1659 by 2212 pixels:
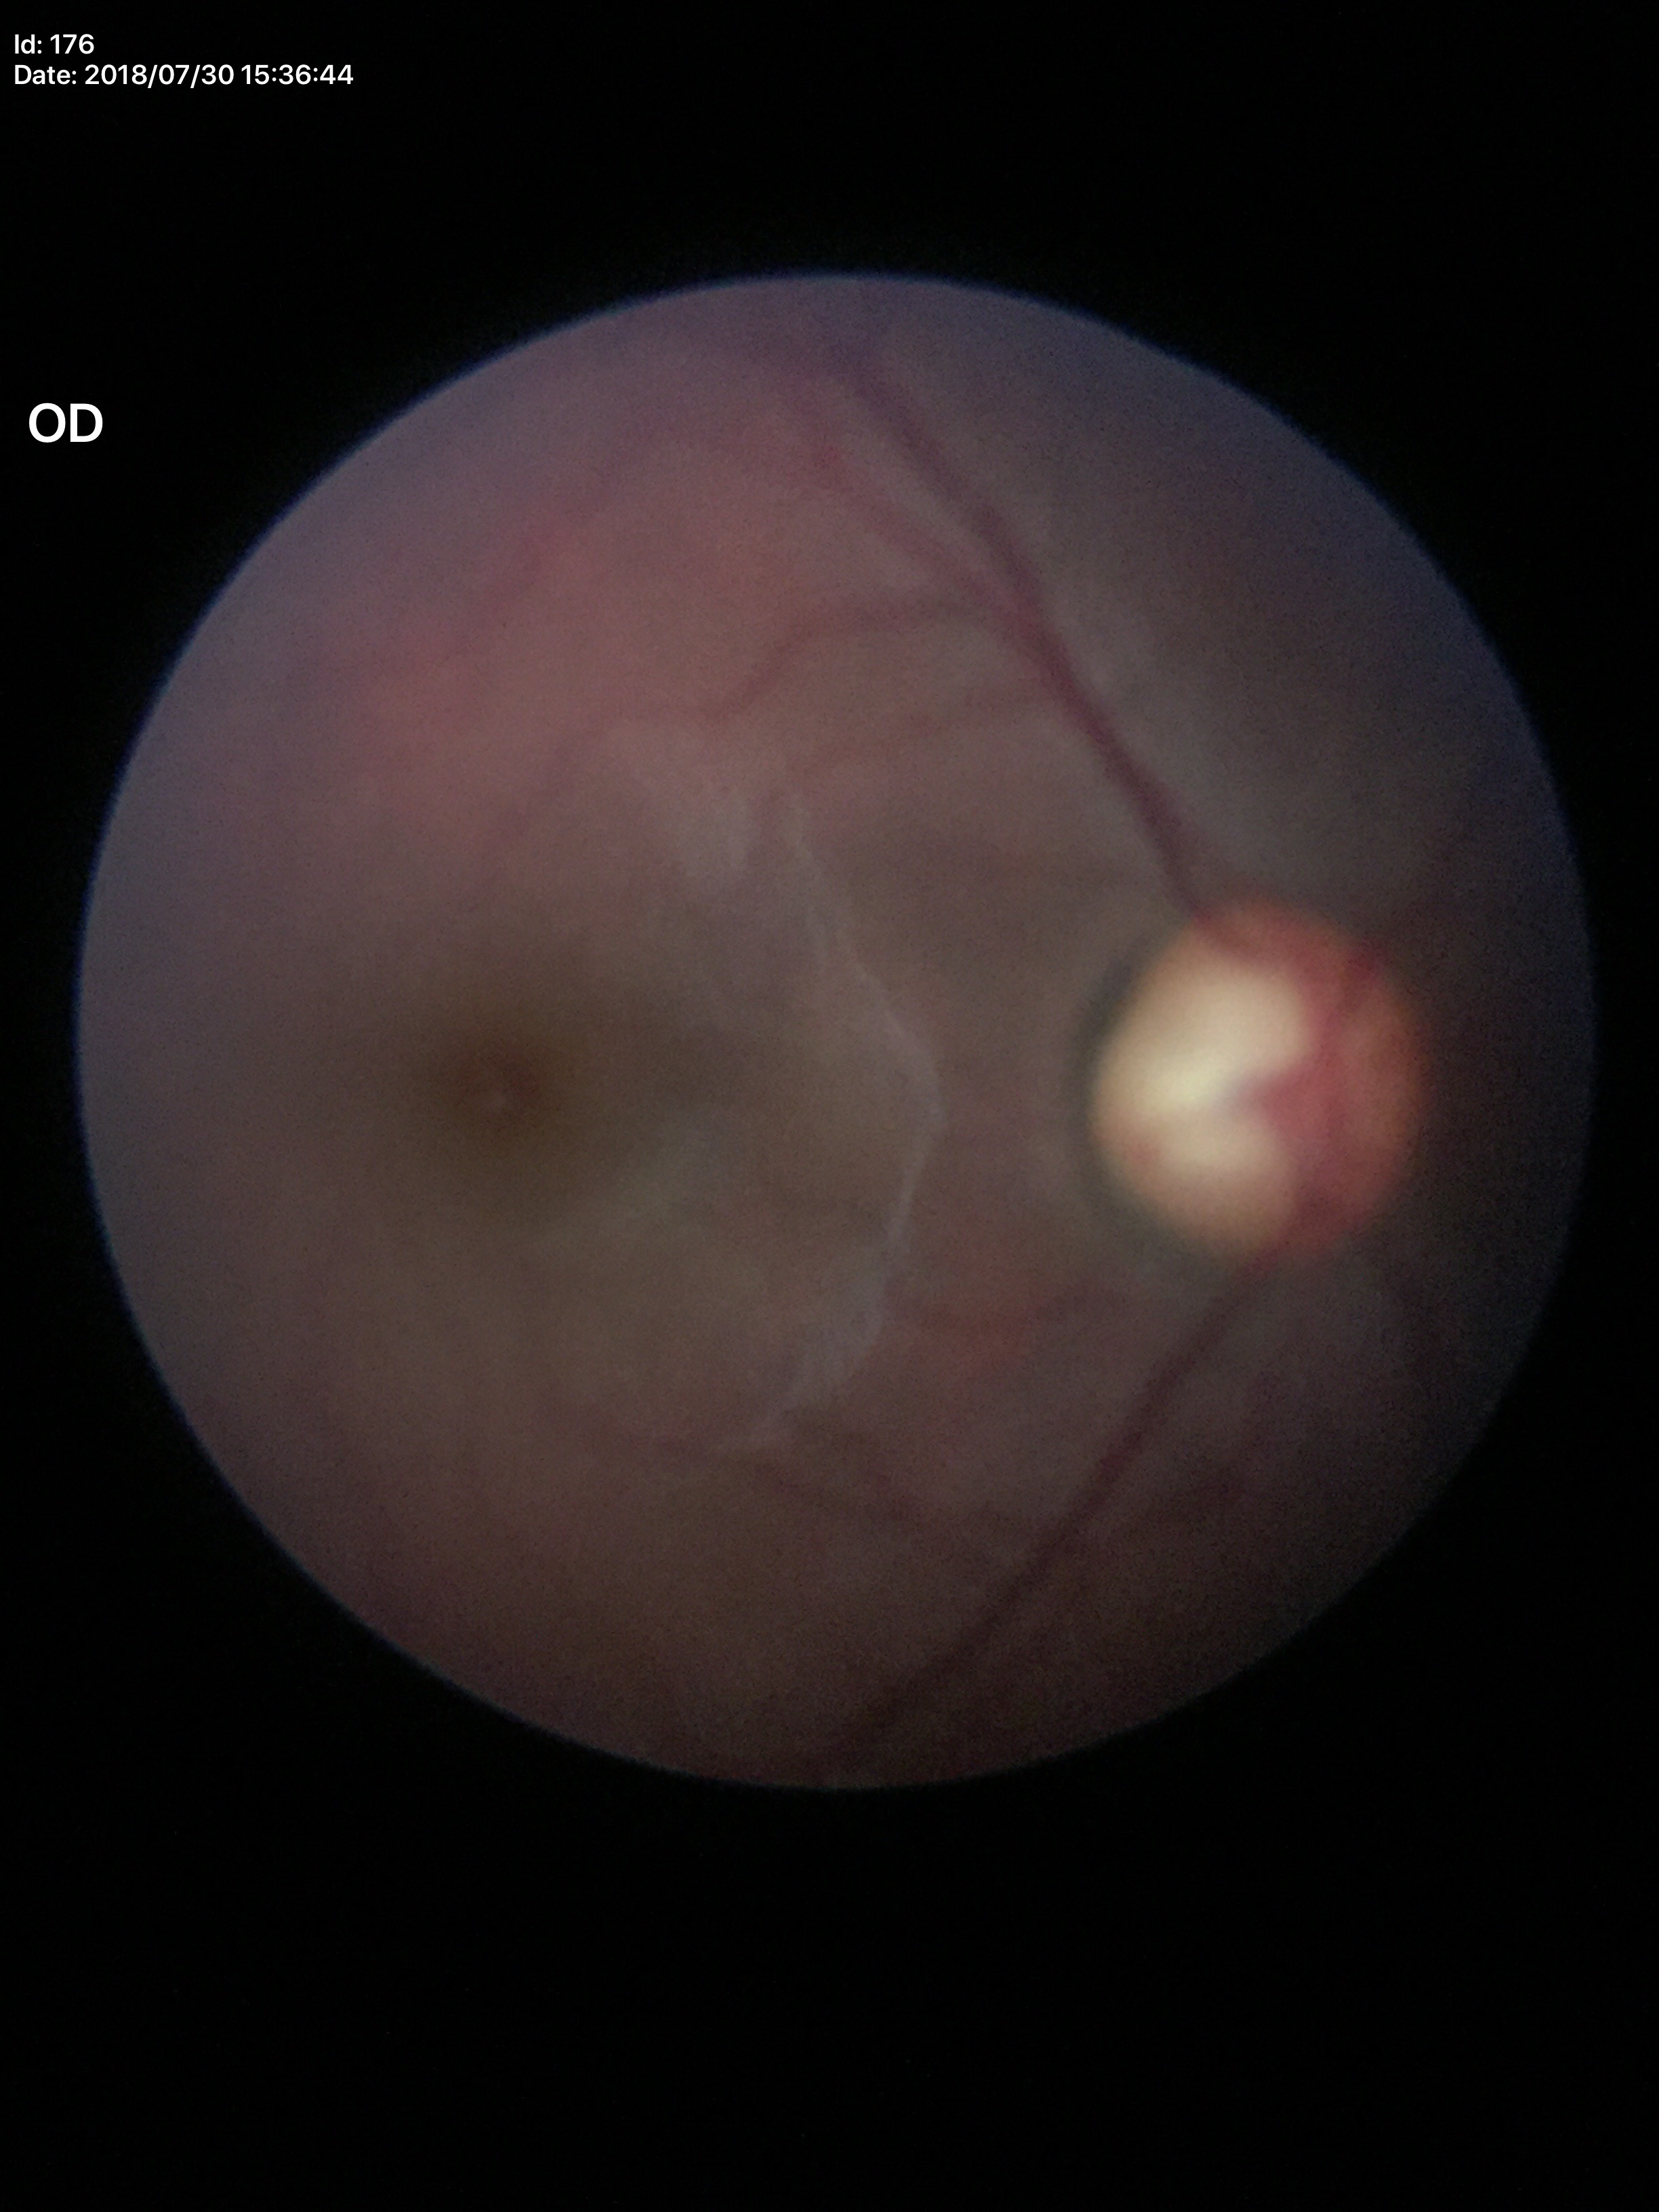
Glaucoma evaluation: suspicious (four of five ophthalmologists flagged glaucoma suspect), vertical cup-disc ratio (VCDR): 0.65, horizontal cup-disc ratio (HCDR): 0.65.